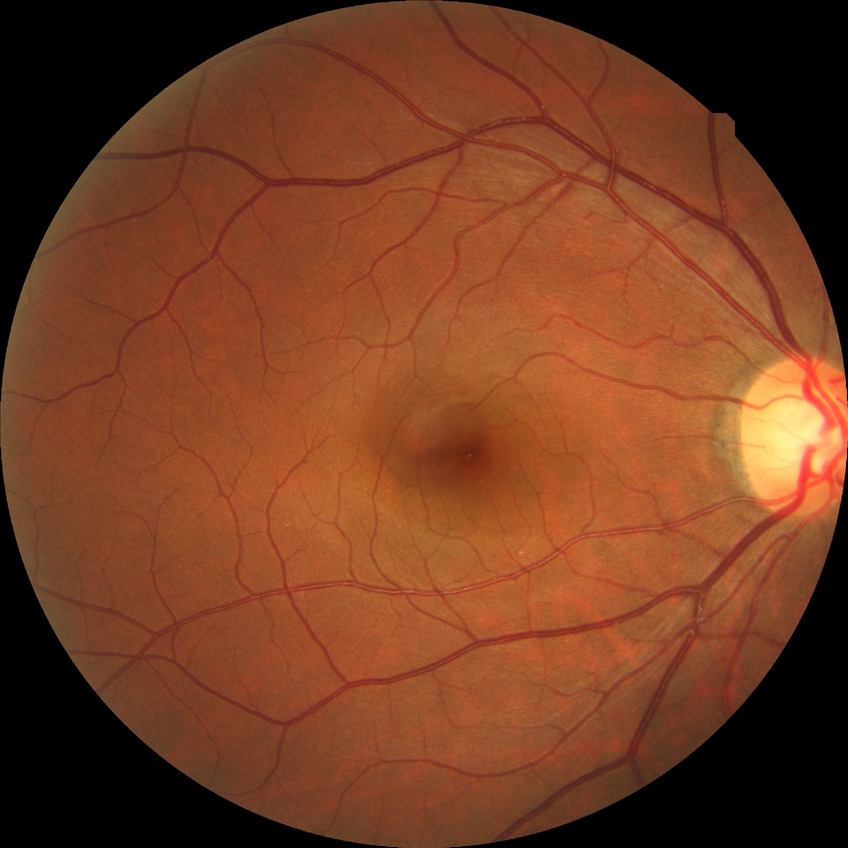 Diabetic retinopathy (DR) is NDR (no diabetic retinopathy).